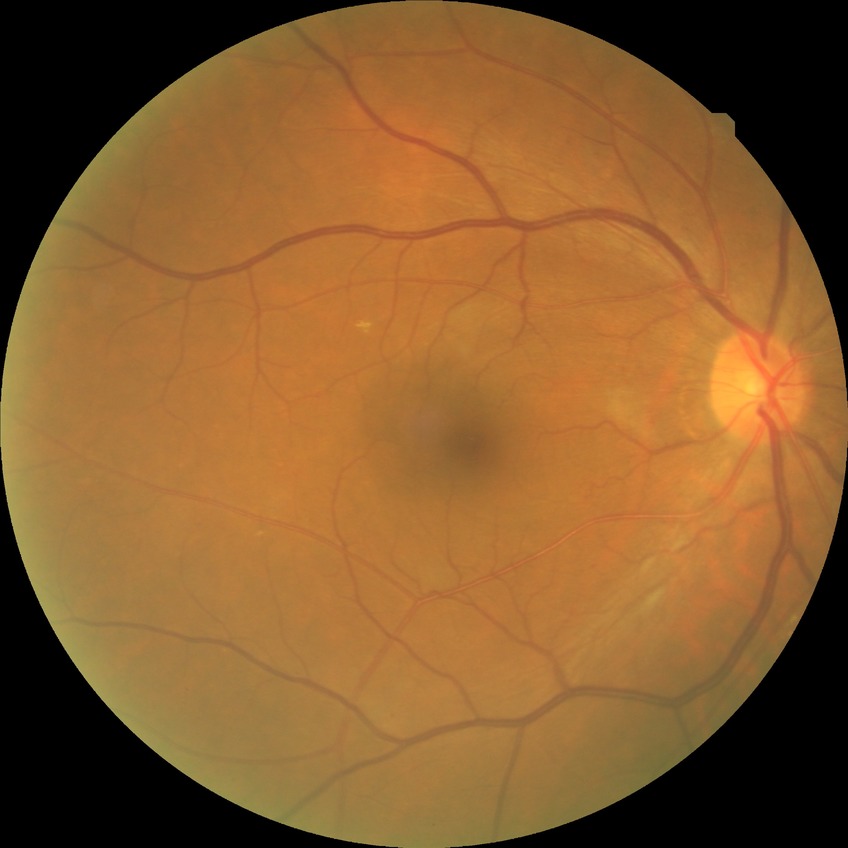

diabetic retinopathy (DR): simple diabetic retinopathy (SDR)